240x240px: 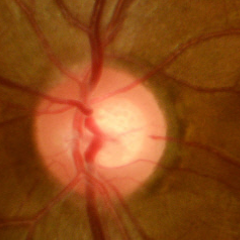 Showing no glaucoma.